Diabetic retinopathy graded by the modified Davis classification.
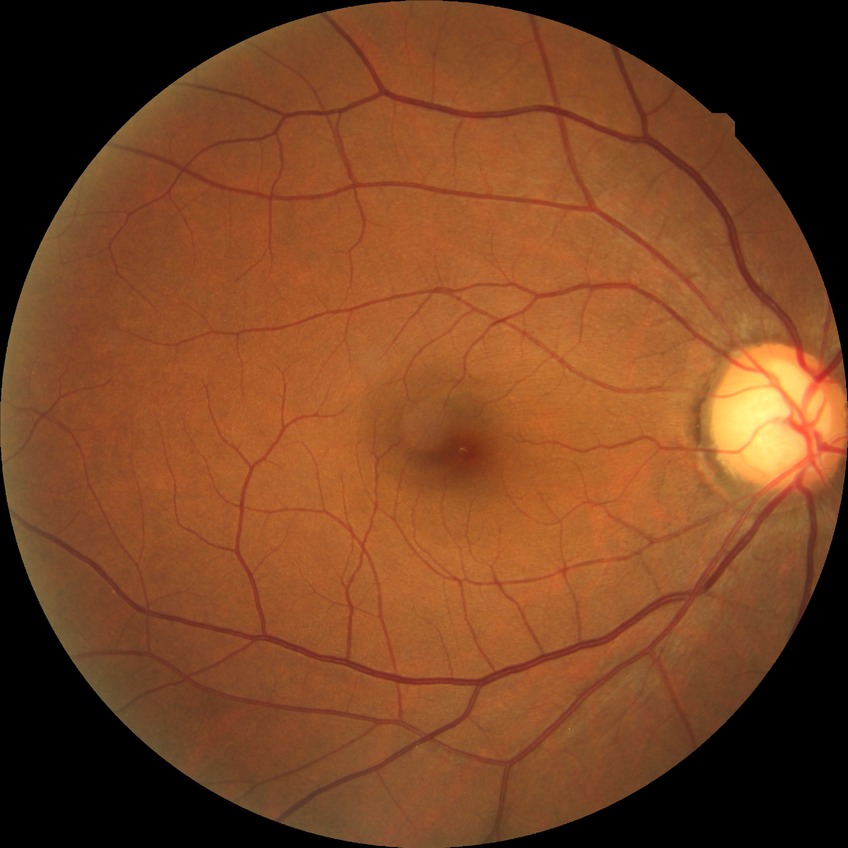 Davis grading: no diabetic retinopathy.